Pupil-dilated, FOV: 50 degrees, posterior pole view, 2228x1652px.
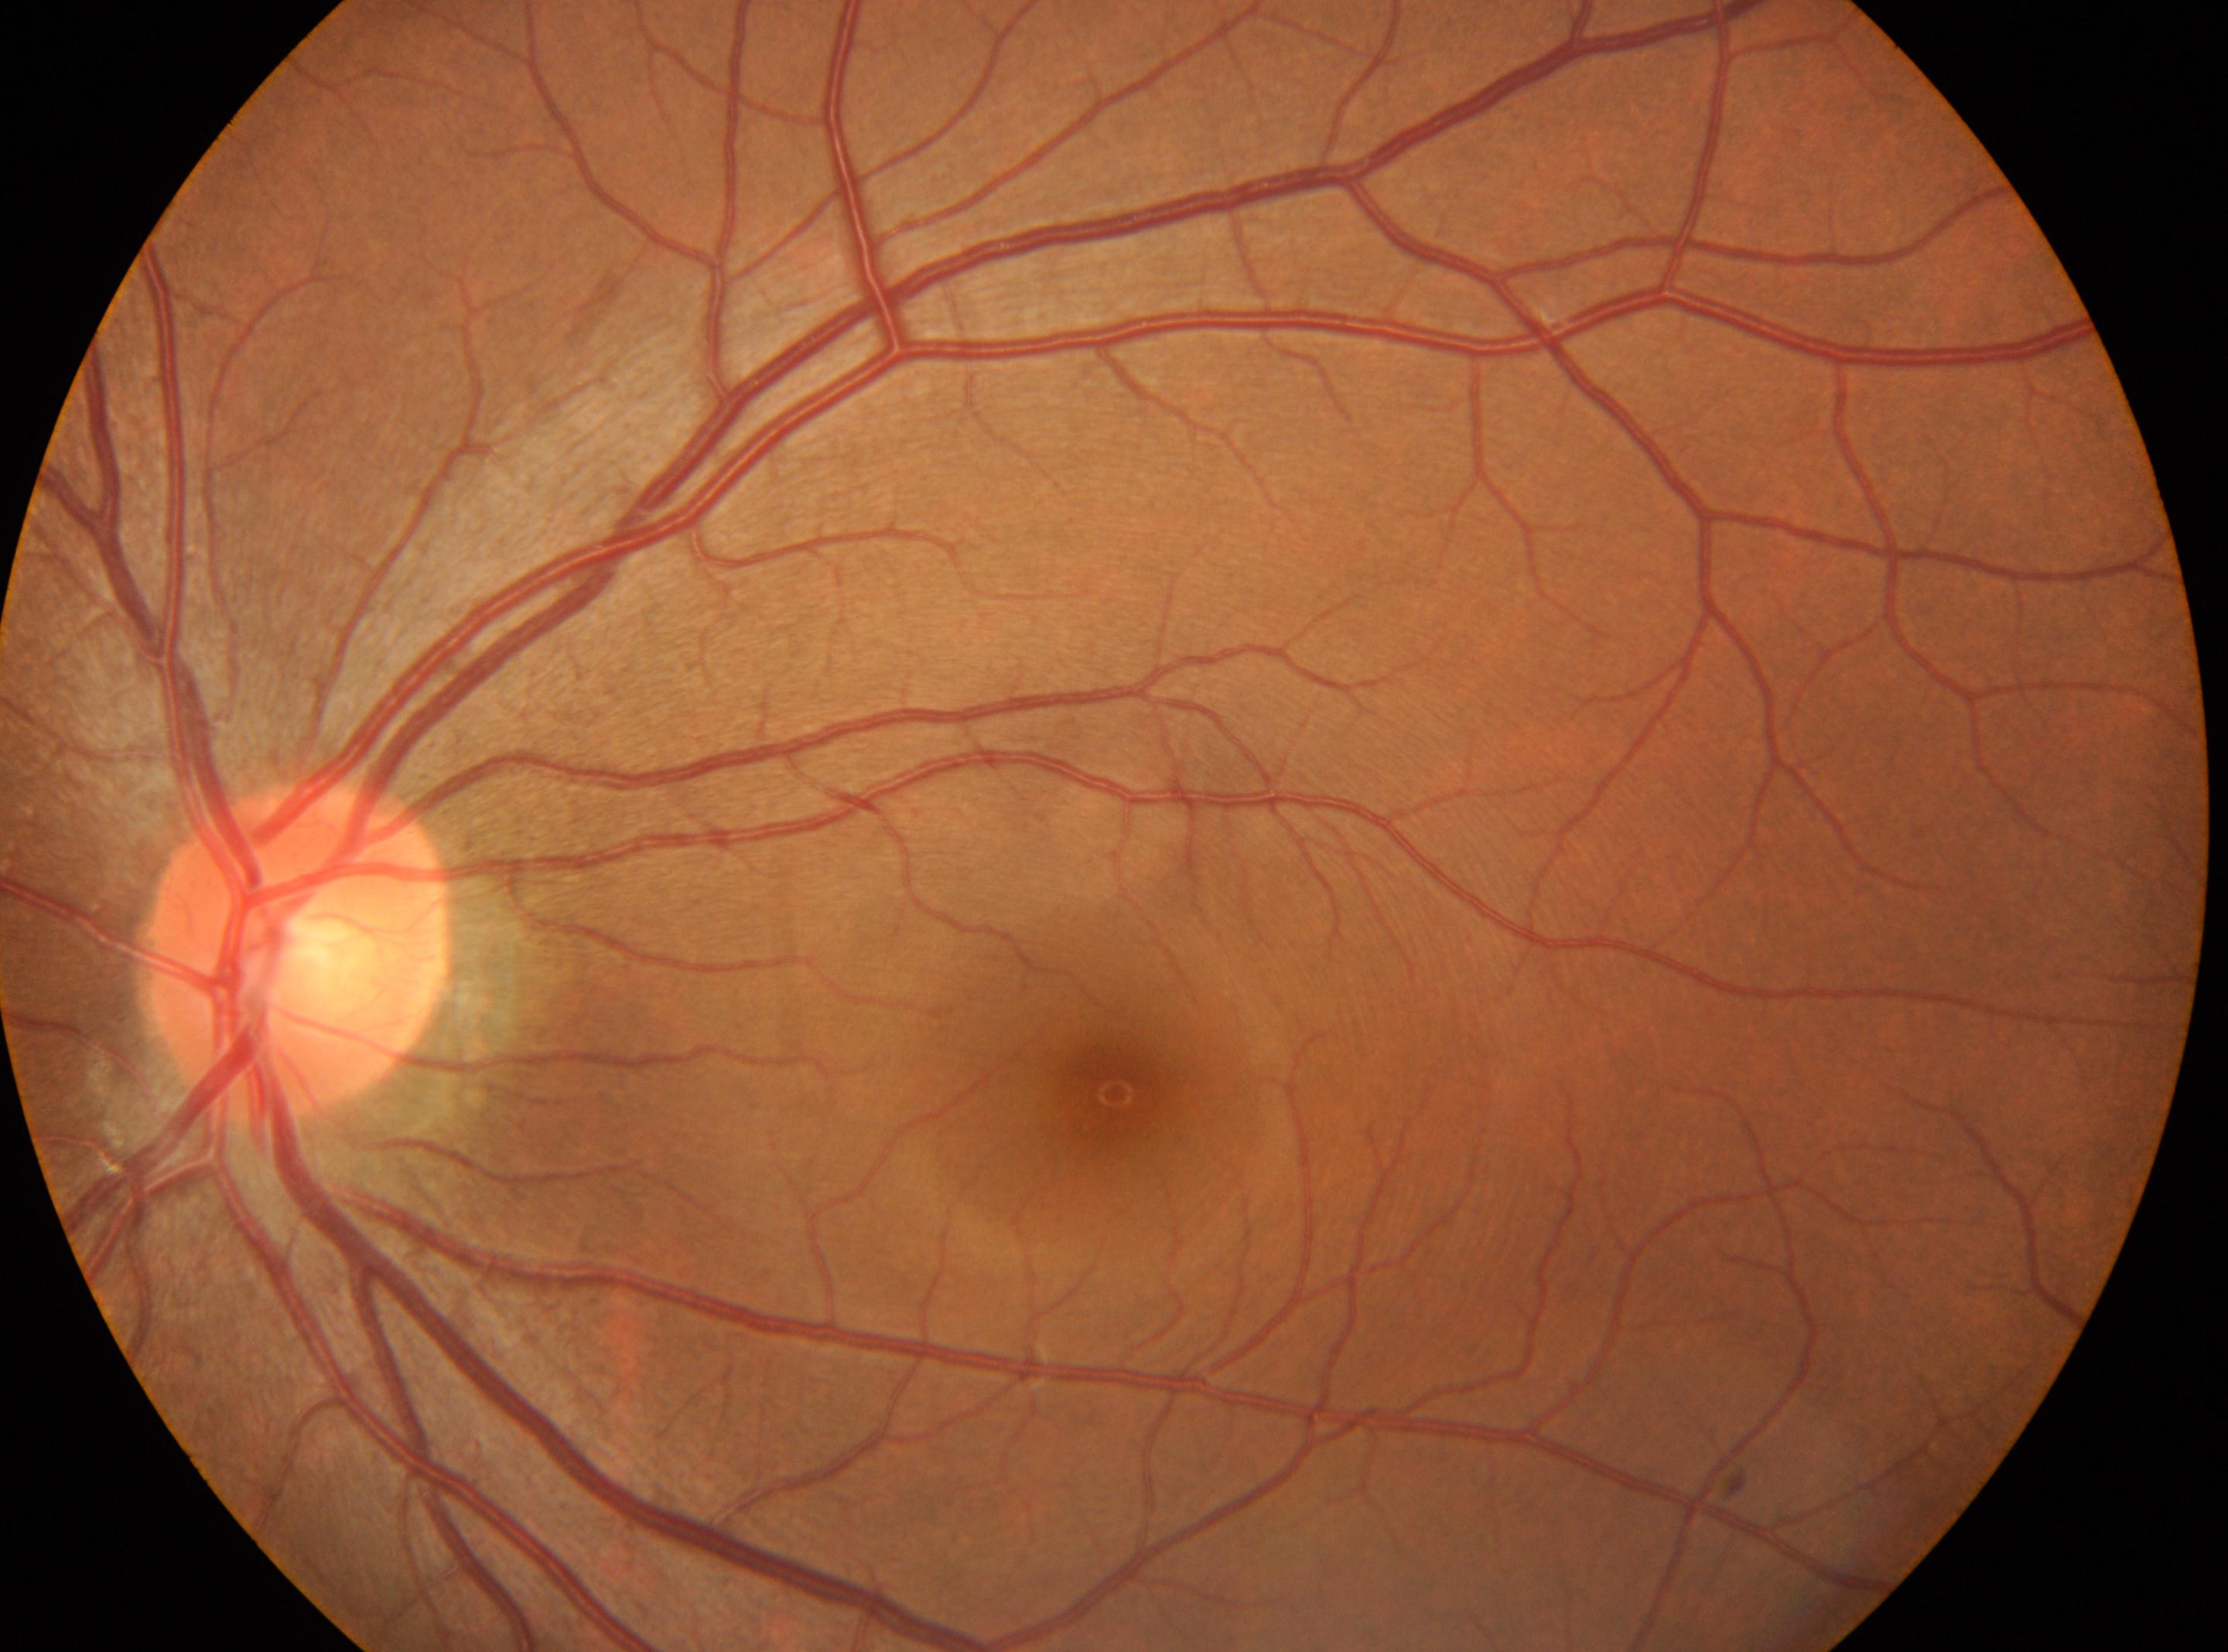 | field | value |
|---|---|
| optic disc | 296px, 949px |
| DR grade | no apparent retinopathy (0) |
| laterality | left eye |
| fovea | 1114px, 1092px |
| DR impression | No DR findings |